Pediatric retinal photograph (wide-field):
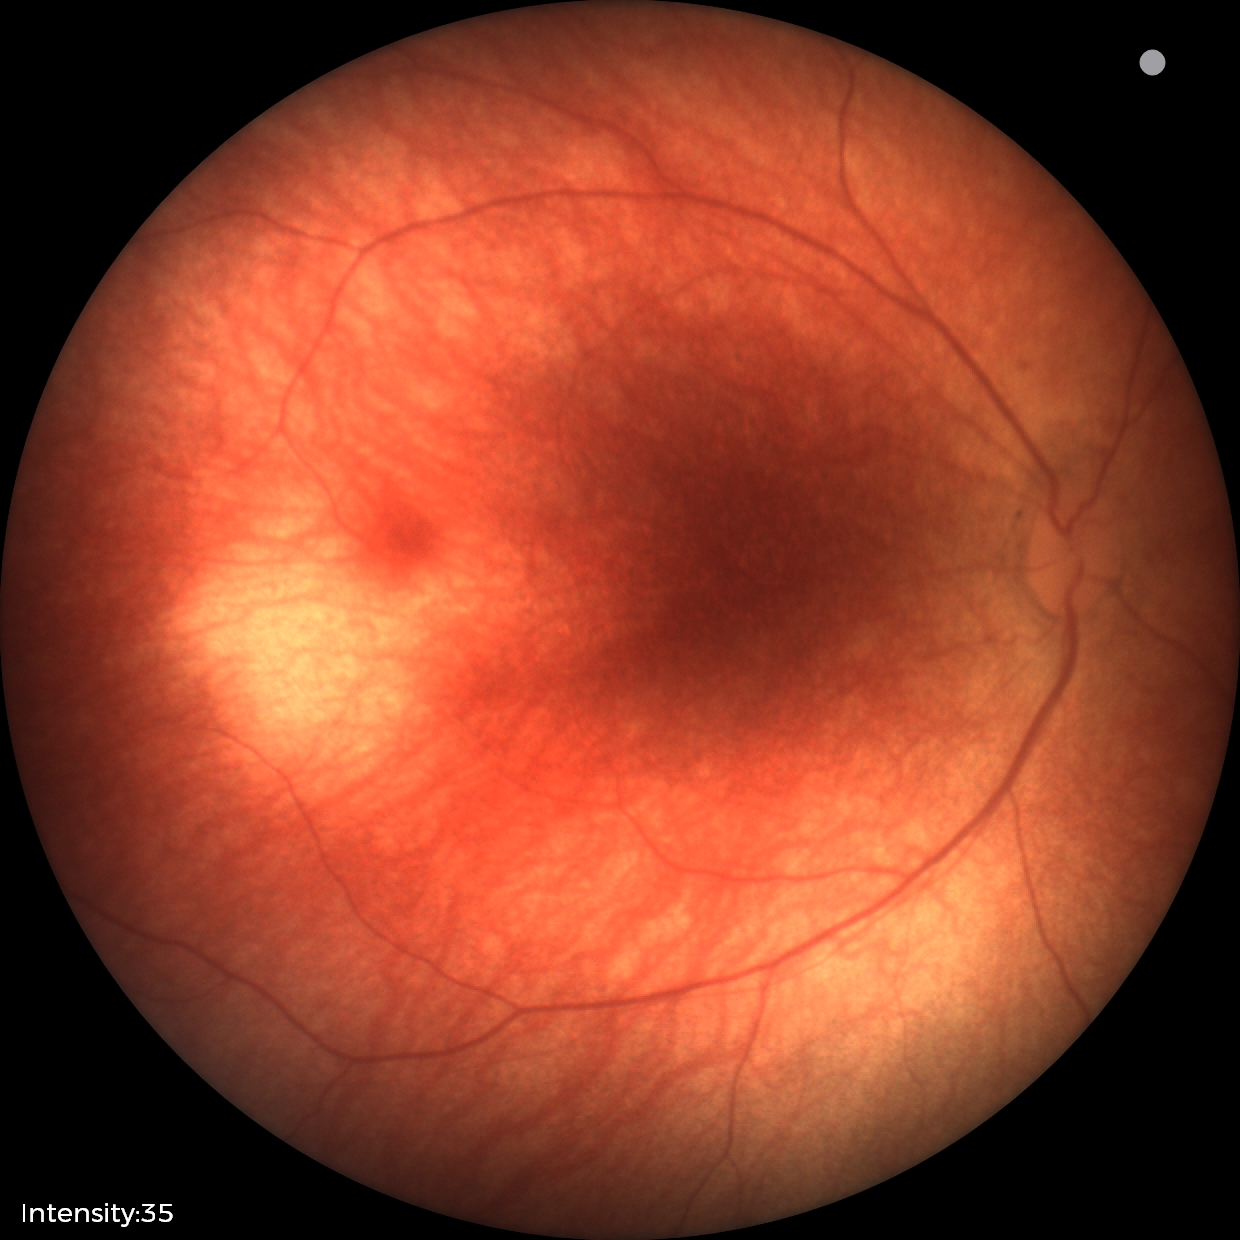
Physiological retinal appearance for postconceptual age.